Wide-field fundus photograph of an infant:
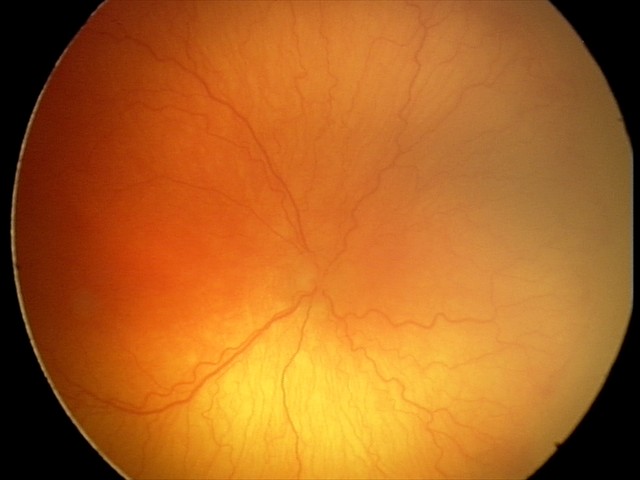 Screening examination consistent with A-ROP (aggressive ROP). Plus disease was diagnosed.